45° FOV:
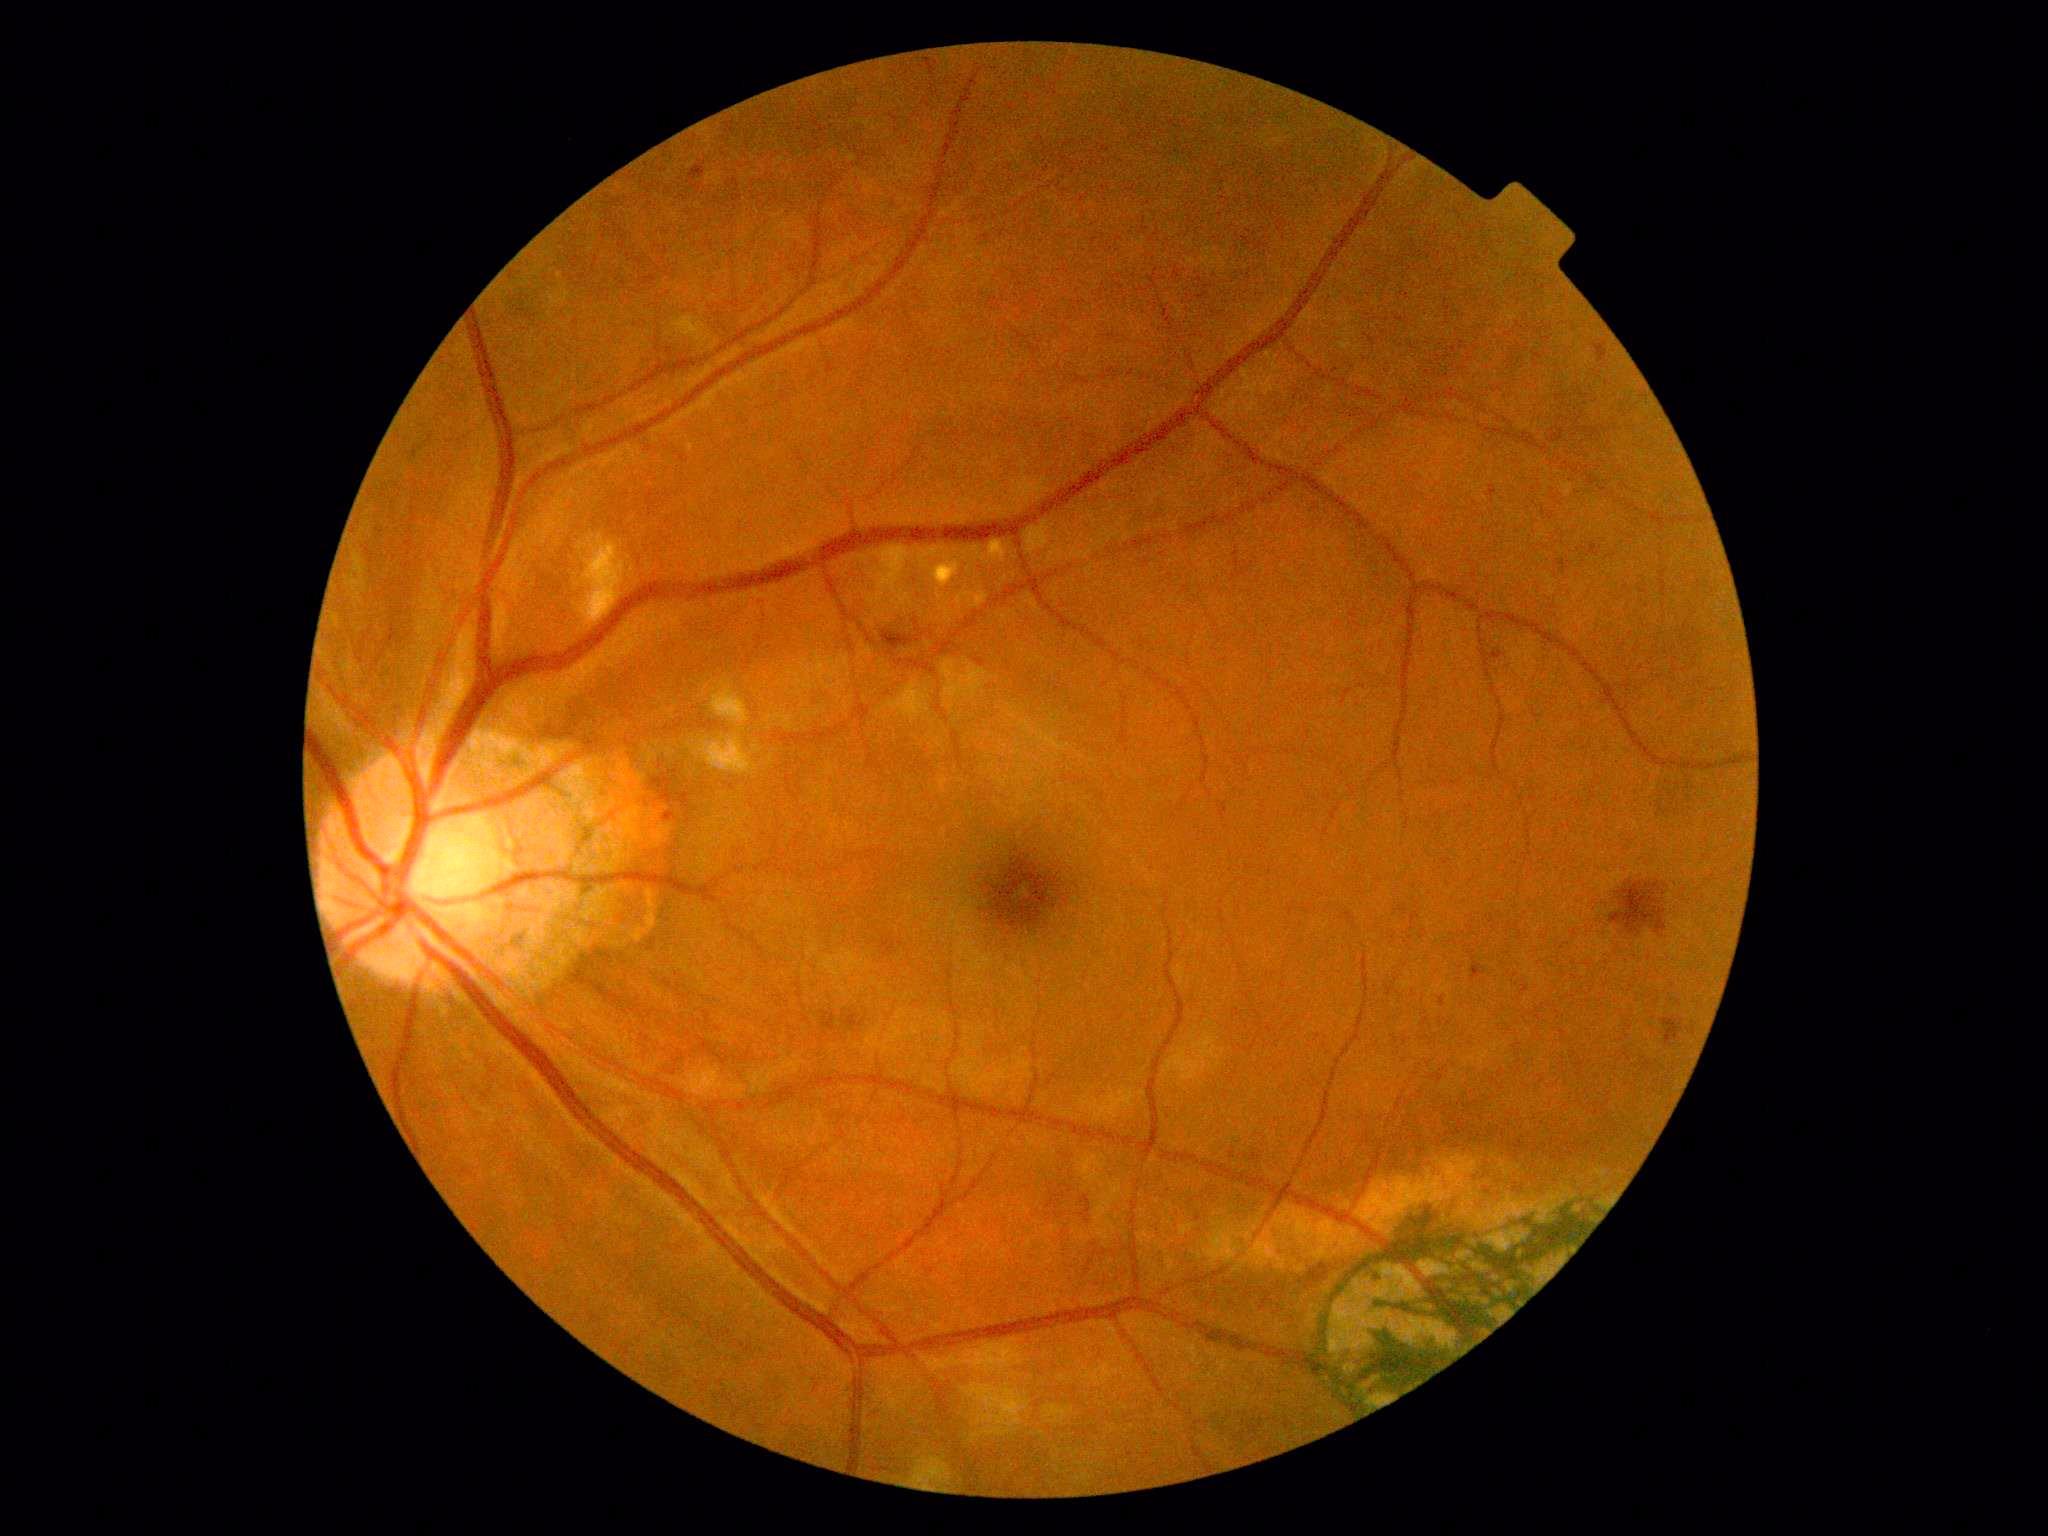 * DR class — non-proliferative diabetic retinopathy
* diabetic retinopathy grade — moderate non-proliferative diabetic retinopathy (2)